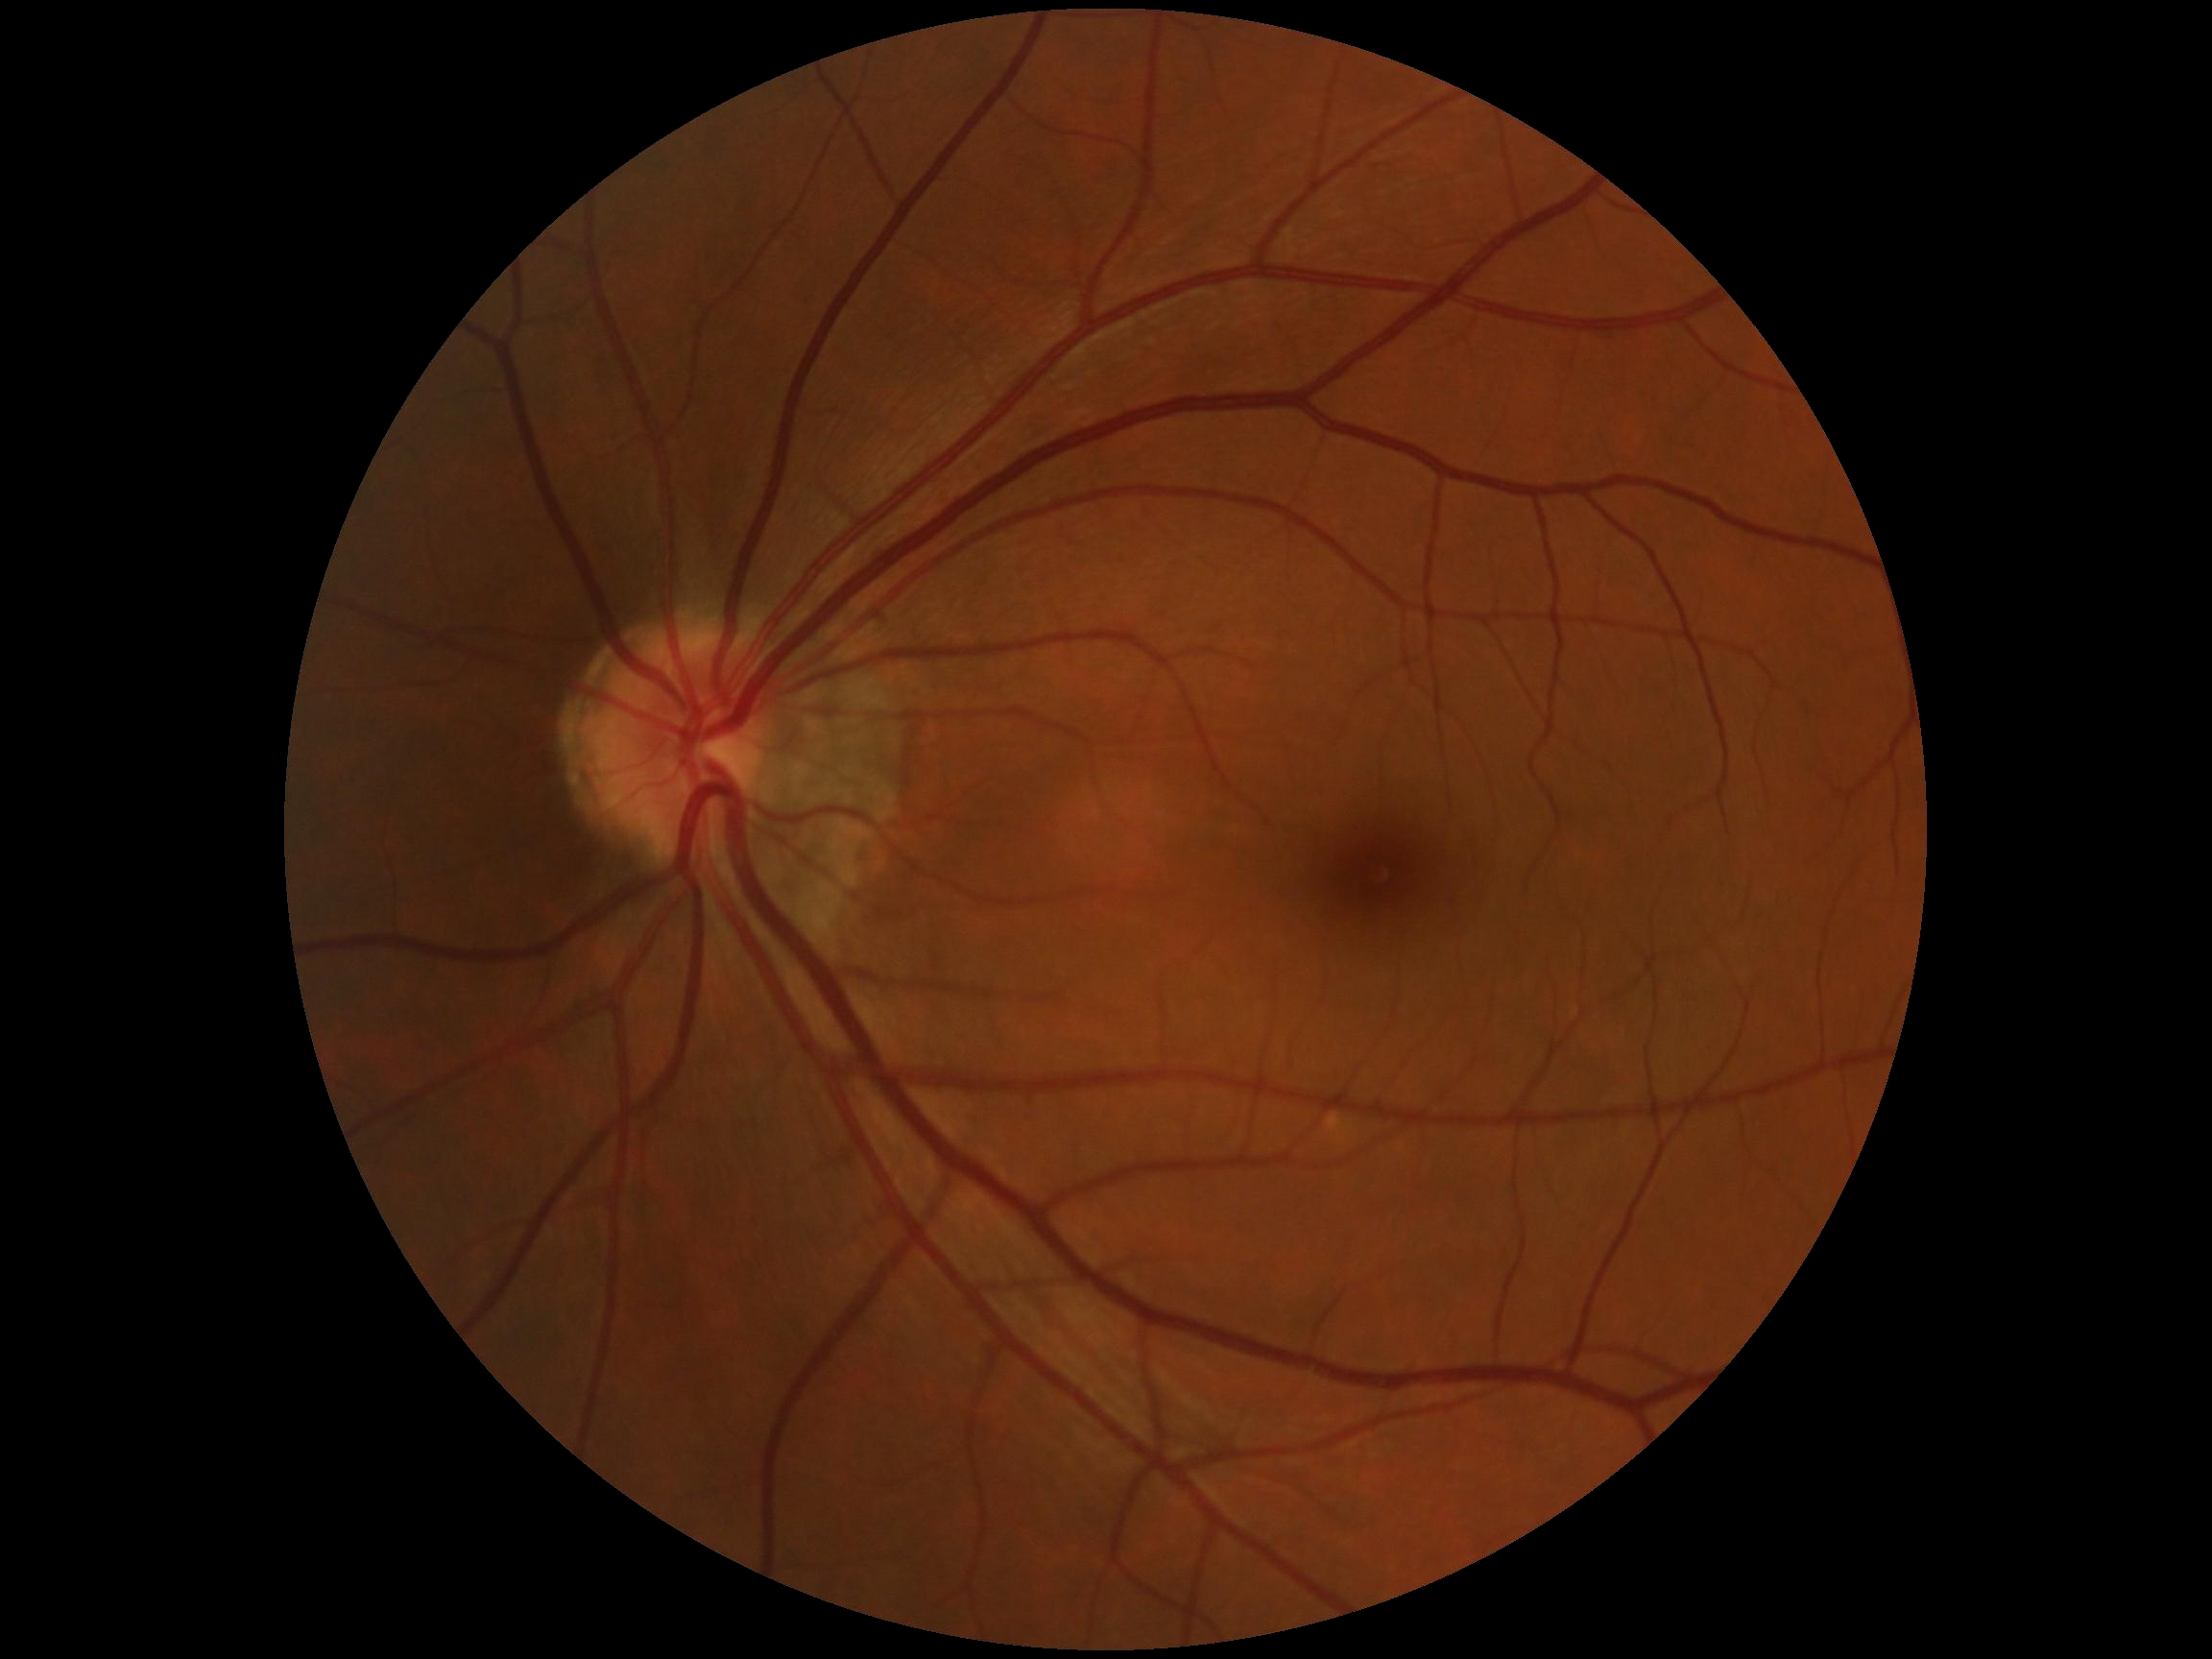

Diabetic retinopathy severity is grade 0.